DR severity per modified Davis staging; camera: NIDEK AFC-230; 45° field of view; without pupil dilation; posterior pole photograph; 848 by 848 pixels — 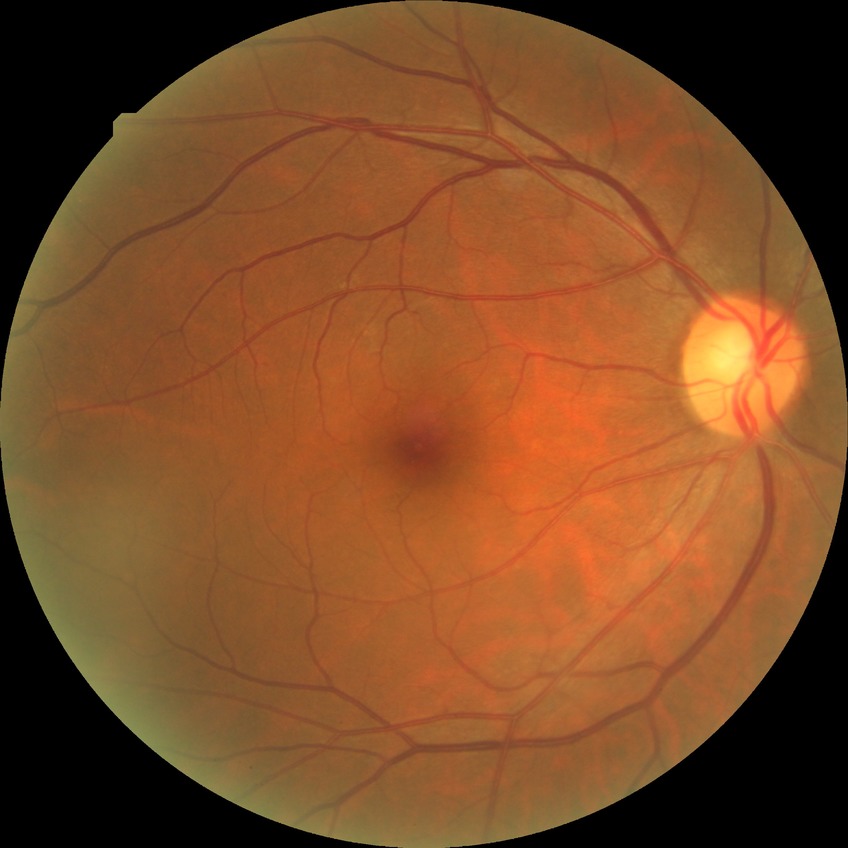 Diabetic retinopathy (DR) is no diabetic retinopathy (NDR).